45 degree fundus photograph · image size 848x848 · NIDEK AFC-230 fundus camera · nonmydriatic fundus photograph — 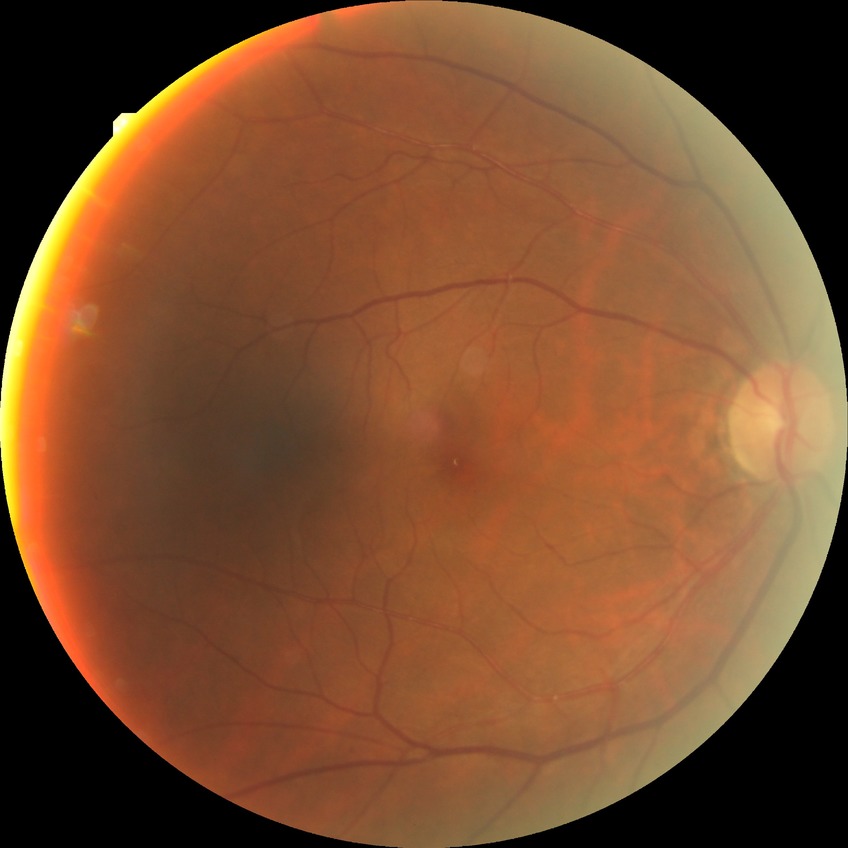 Diabetic retinopathy (DR): NDR (no diabetic retinopathy).